Remidio smartphone fundus camera.
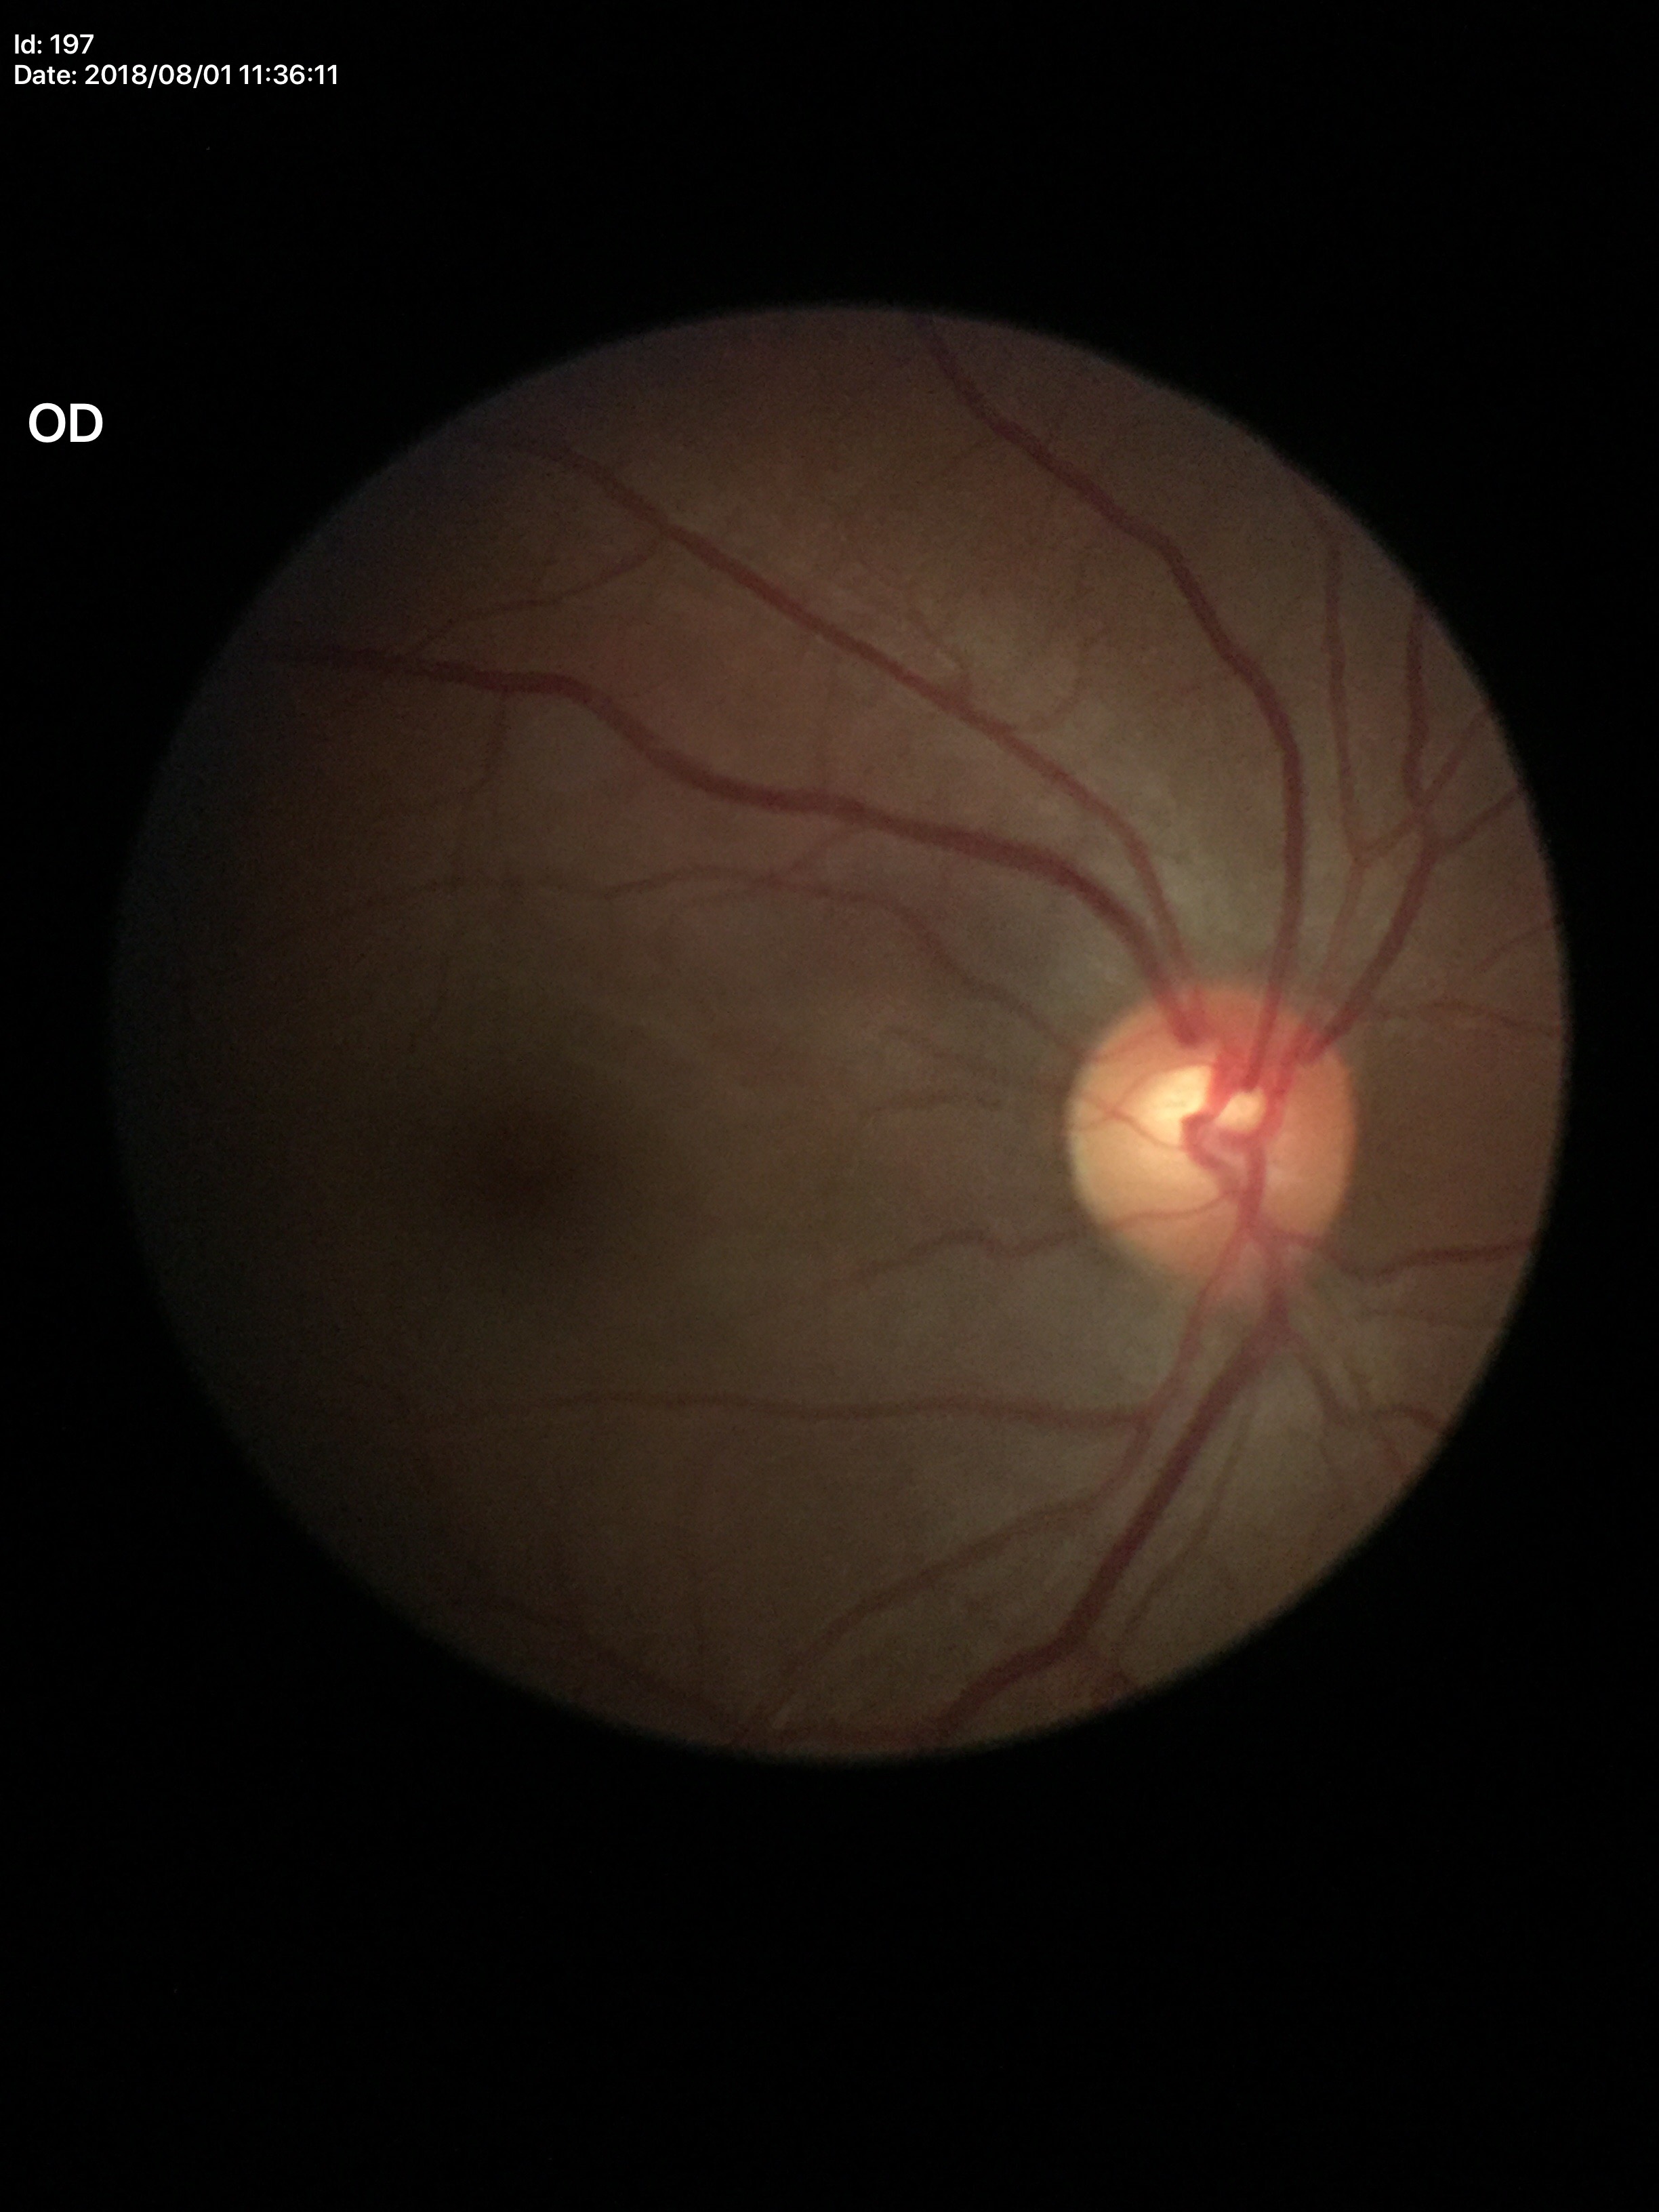
Q: What is the glaucoma assessment?
A: no suspicious findings (one of five ophthalmologists flagged glaucoma suspect)
Q: Vertical CDR?
A: 0.58
Q: What is the horizontal cup-to-disc ratio?
A: 0.59